Davis DR grading · color fundus image · without pupil dilation · acquired with a NIDEK AFC-230
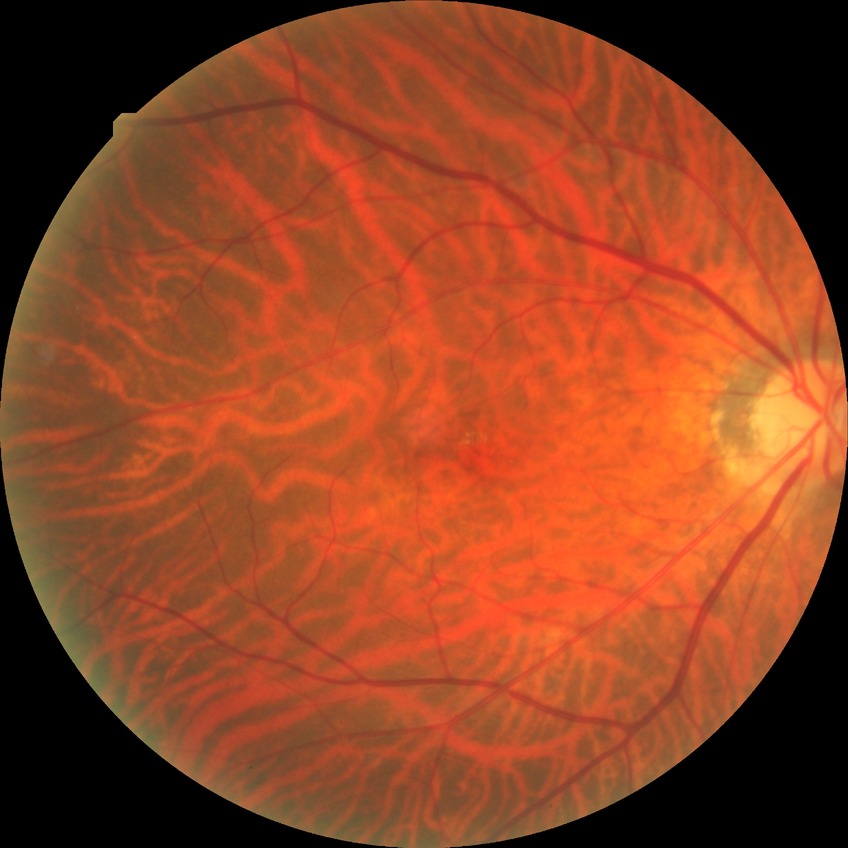 Diabetic retinopathy (DR) is no diabetic retinopathy (NDR).